Infant wide-field retinal image · camera: Clarity RetCam 3 (130° FOV) · image size 640x480: 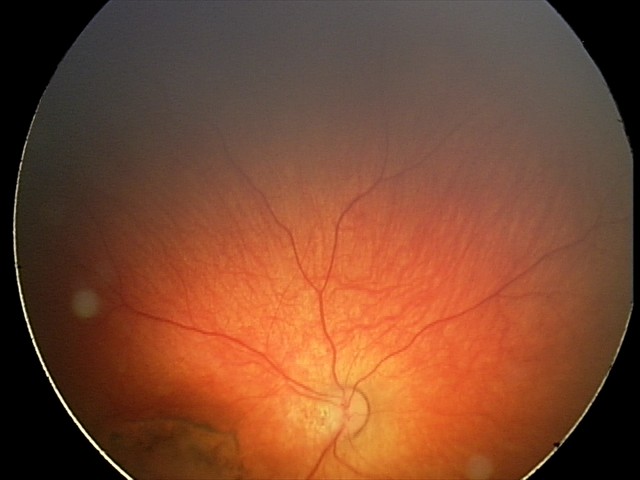 Screening diagnosis: toxoplasmosis chorioretinitis.